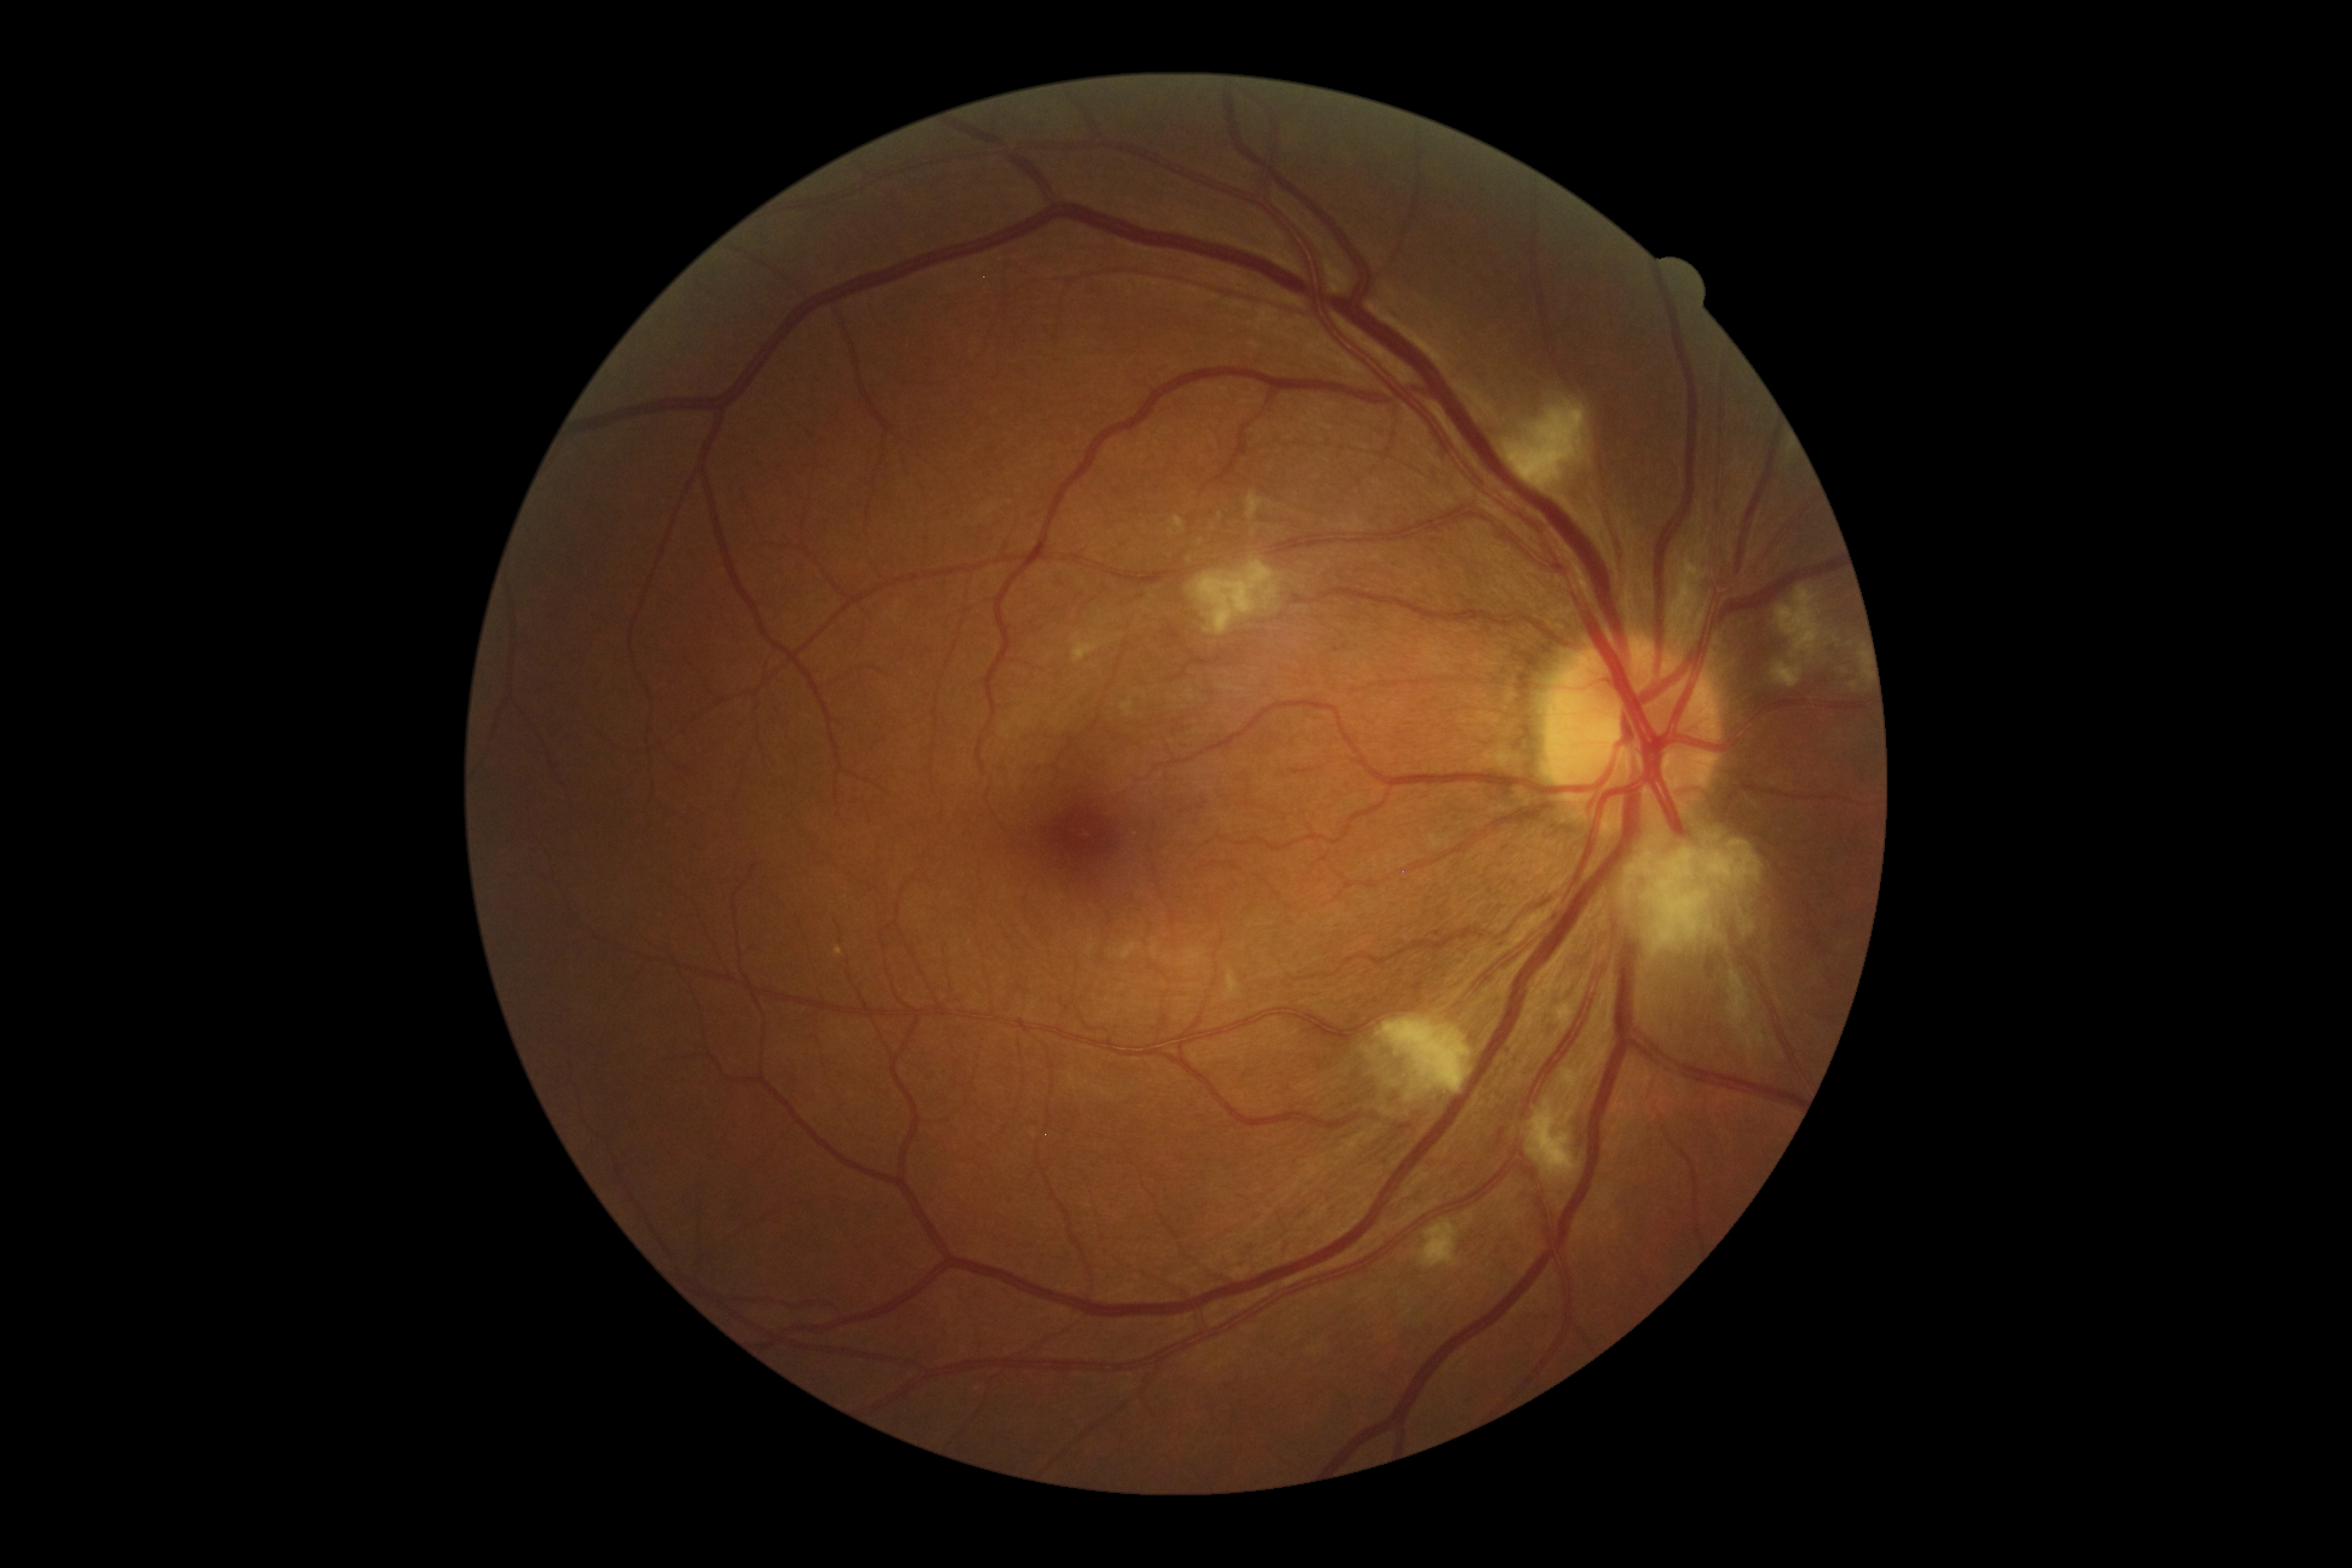

Findings:
• DR class: non-proliferative diabetic retinopathy
• retinopathy: grade 2